Nonmydriatic fundus photograph. NIDEK AFC-230 fundus camera.
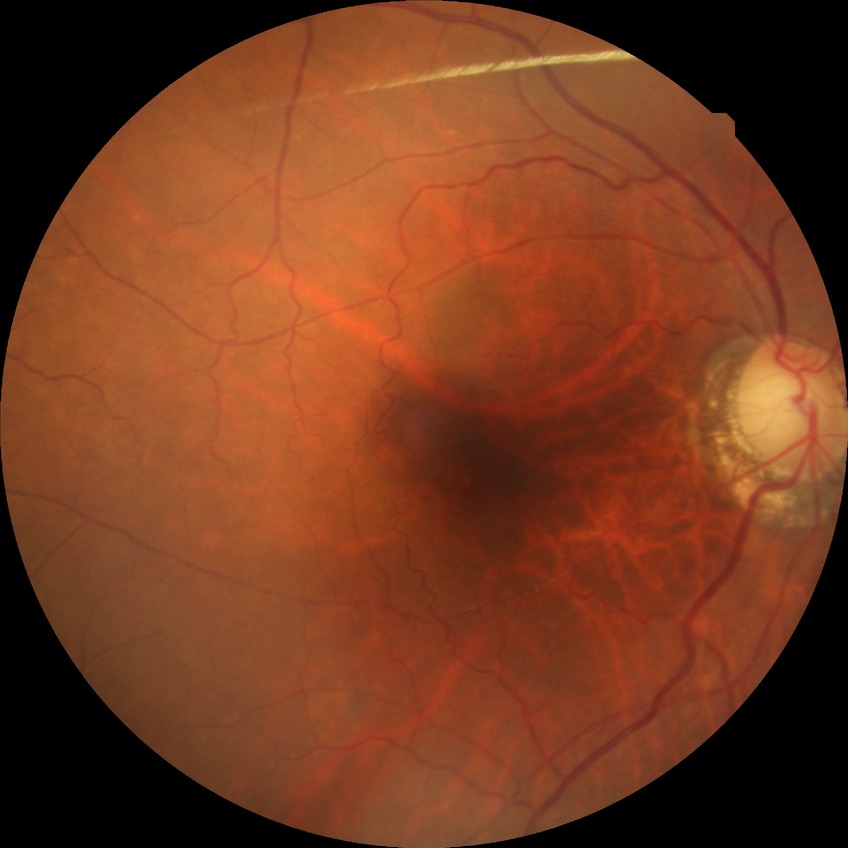
Assessment:
– diabetic retinopathy (DR) — NDR (no diabetic retinopathy)